Image size 240x240 · centered on the optic disc:
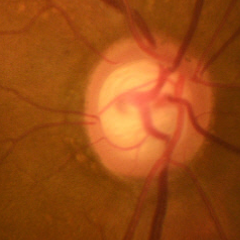

Q: What stage of glaucoma is present?
A: Yes — early glaucomatous optic neuropathy.